Diabetic retinopathy graded by the modified Davis classification
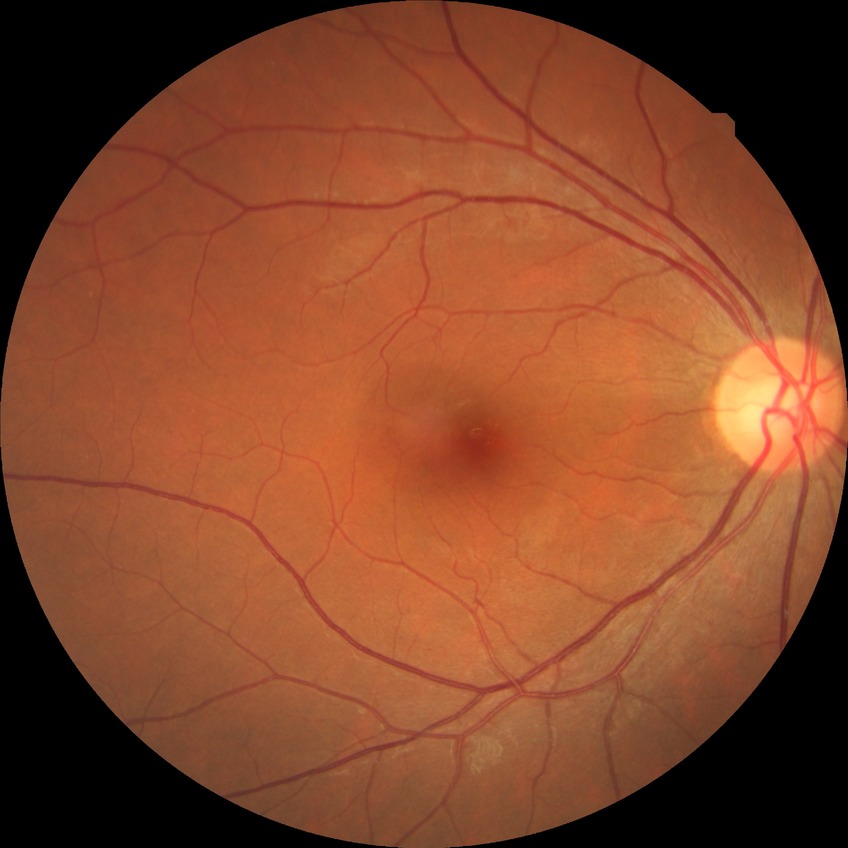 {"dr_impression": "negative for DR", "davis_grade": "NDR"}